45° field of view · image size 2048x1536 · retinal fundus photograph.
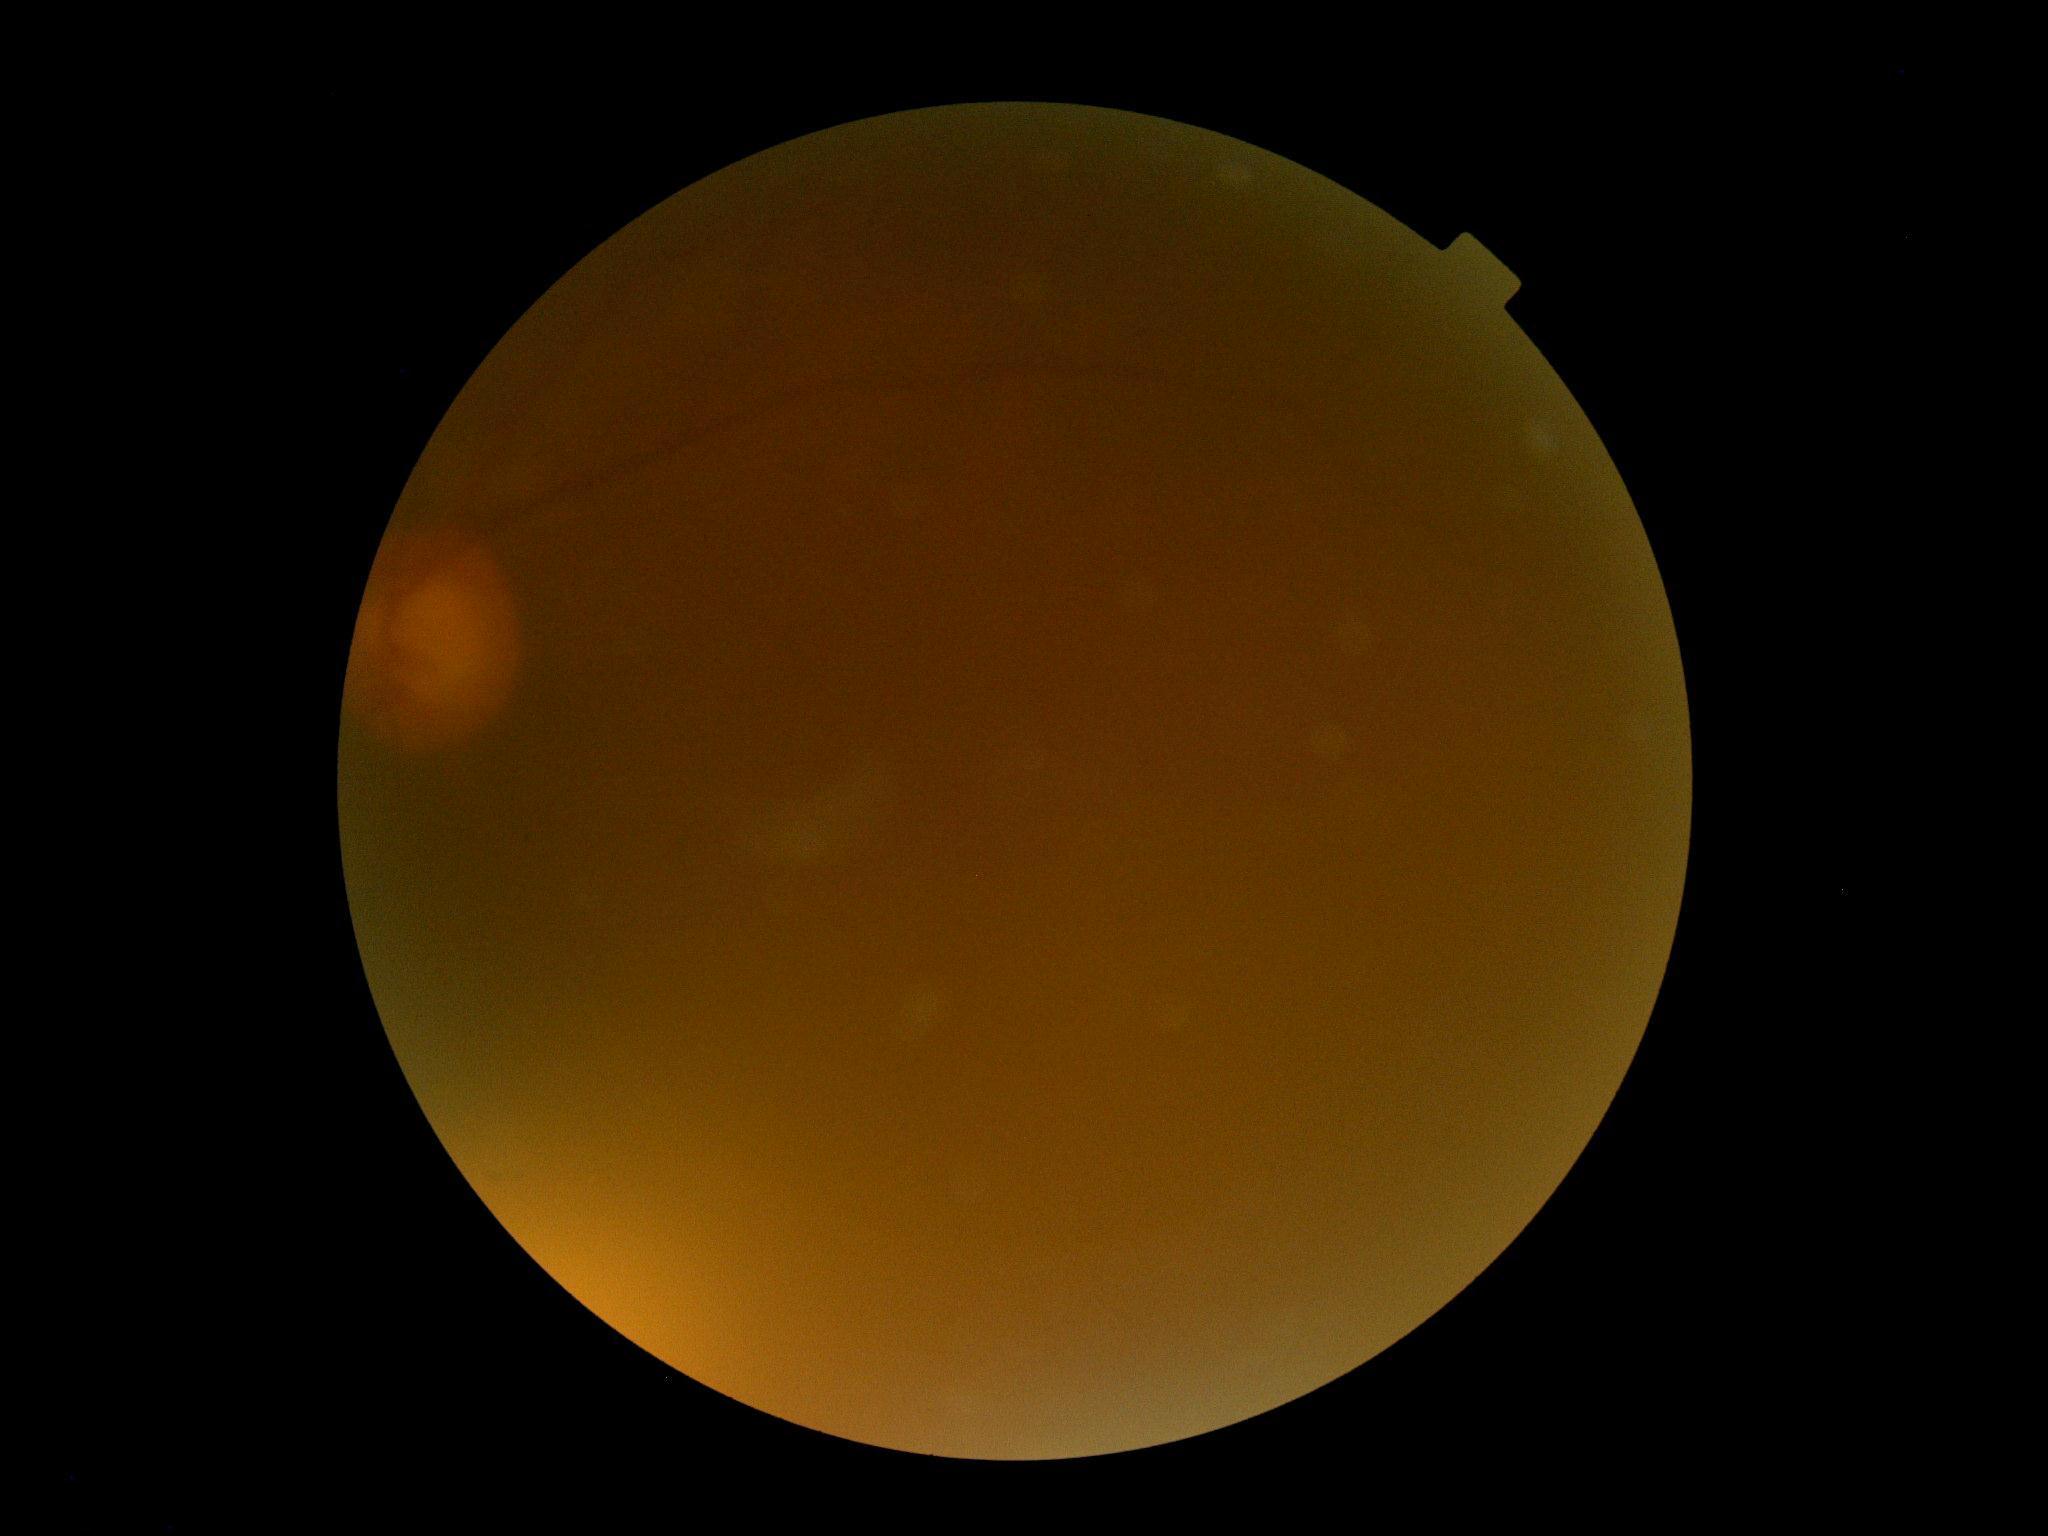 Diabetic retinopathy is ungradable.